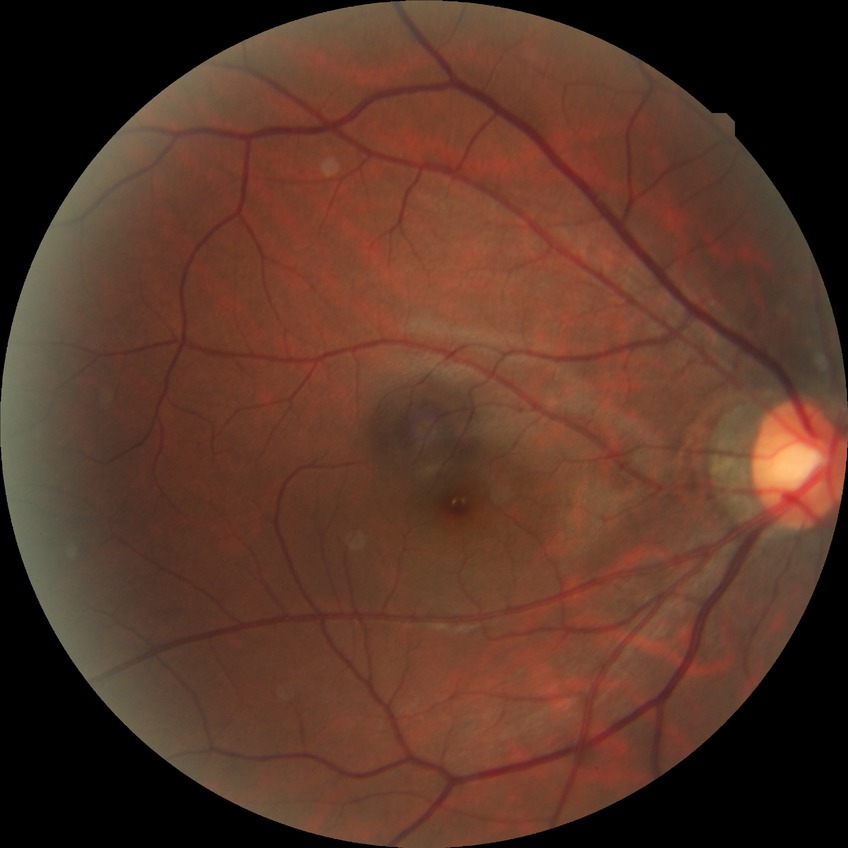
Davis grading: no diabetic retinopathy.